1240x1240. Wide-field contact fundus photograph of an infant.
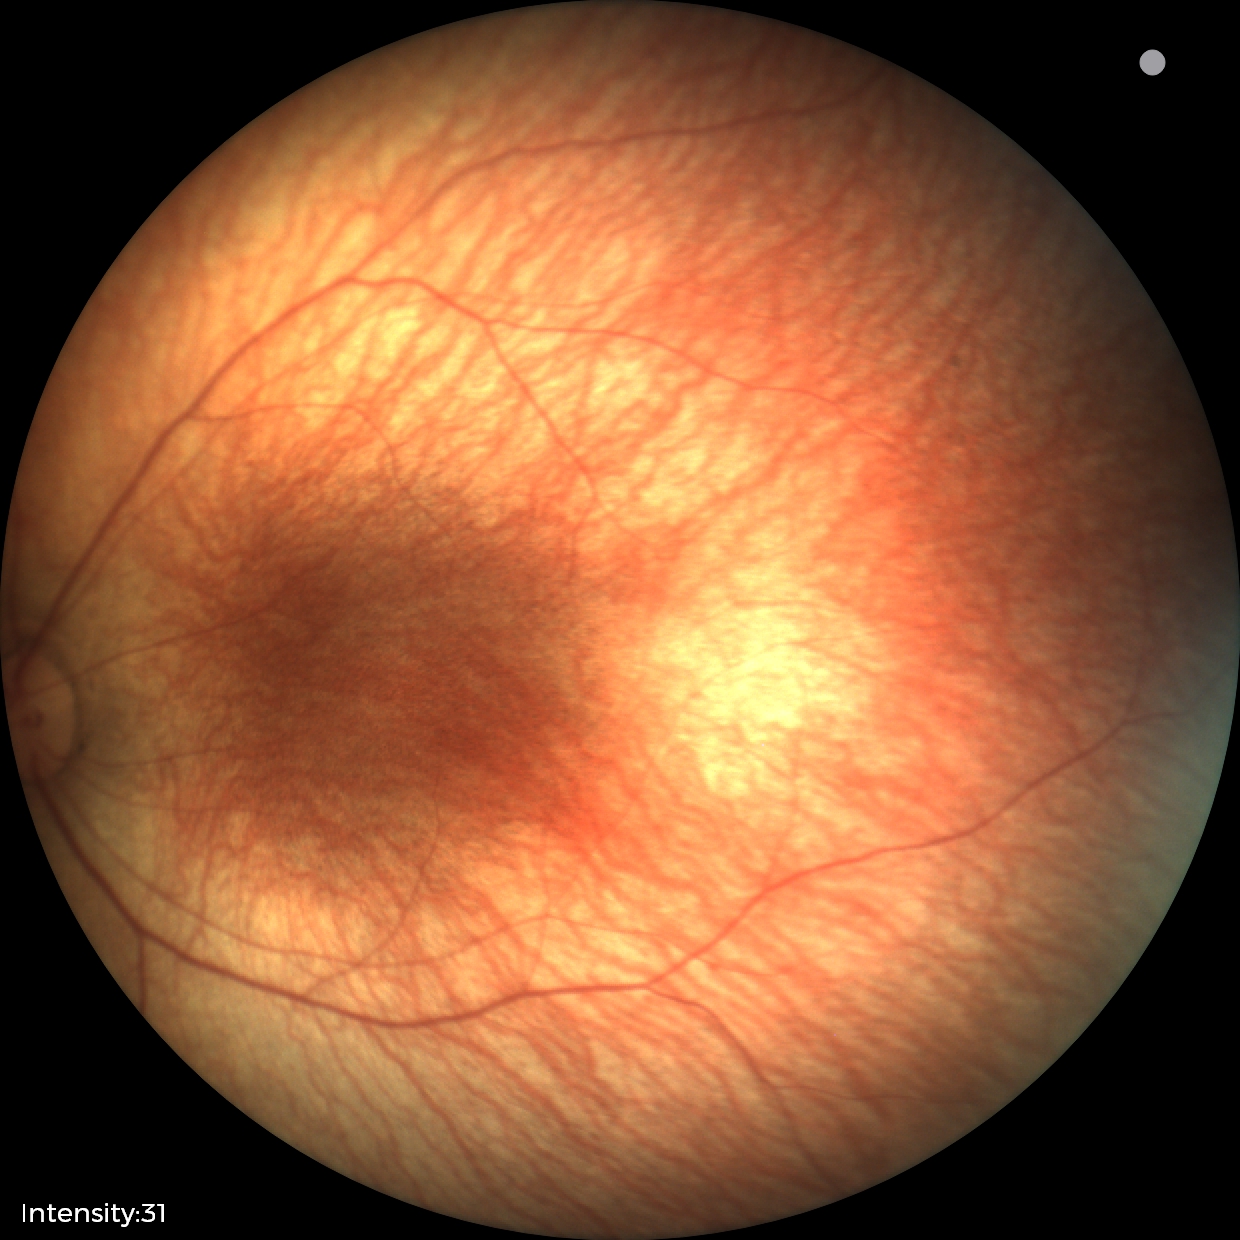

Screening examination with no abnormal retinal findings.